Natus RetCam Envision, 130° FOV; infant wide-field retinal image:
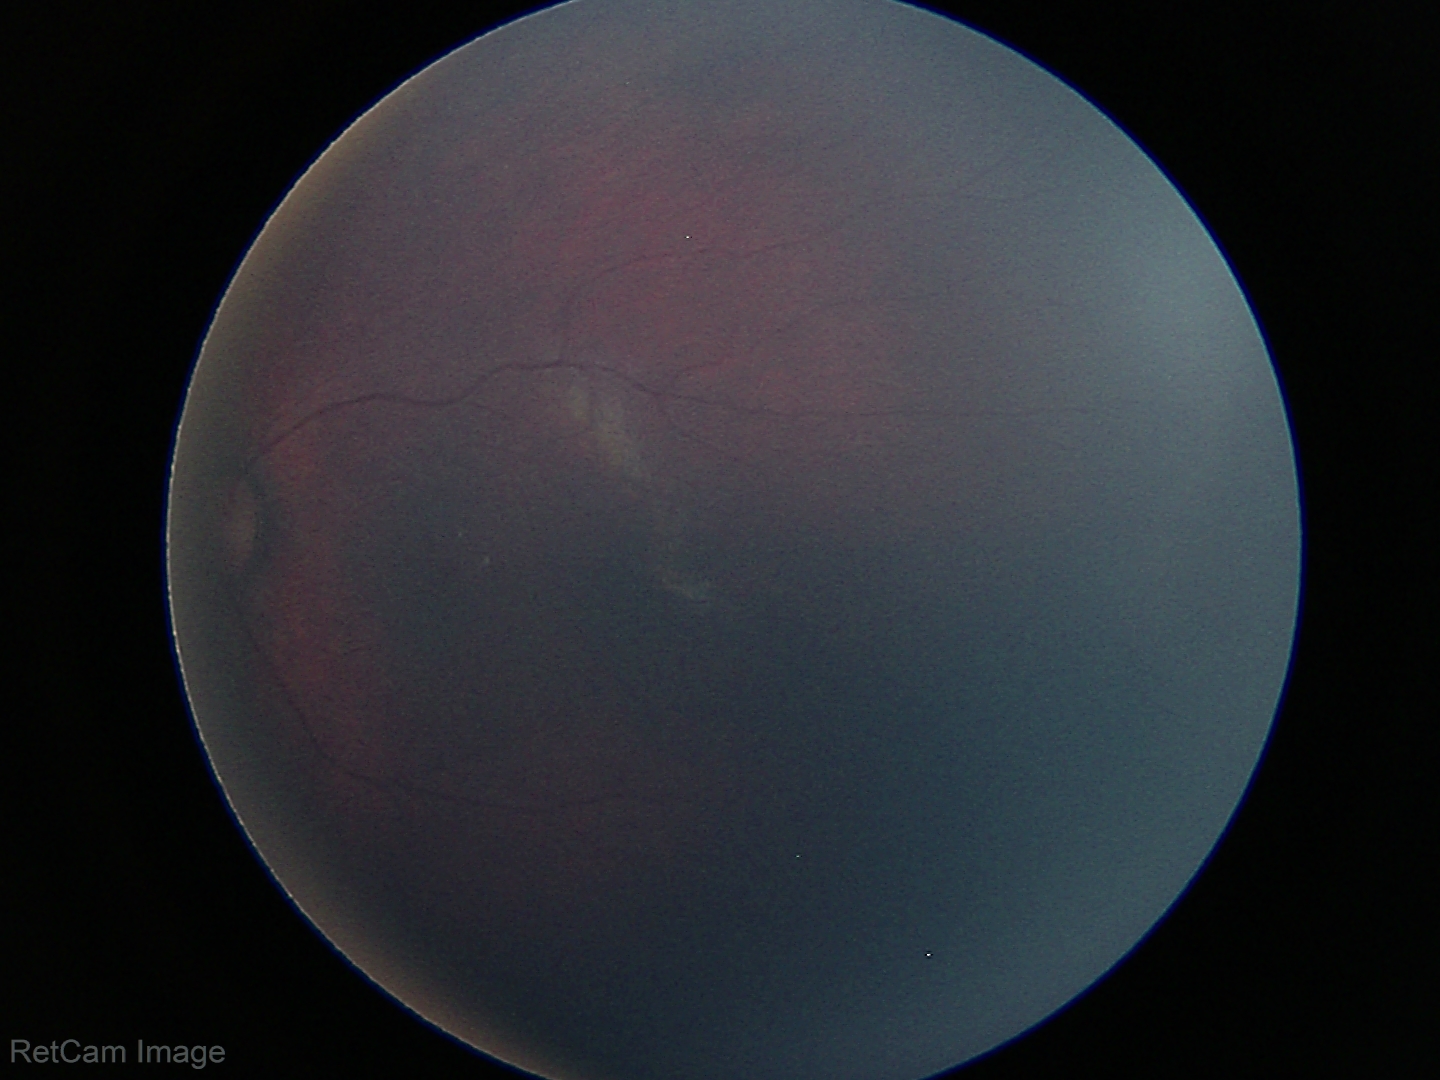 Examination with physiological retinal findings.